FOV 35° before cropping; 460 by 460 pixels; fundus photograph cropped around the optic nerve head — 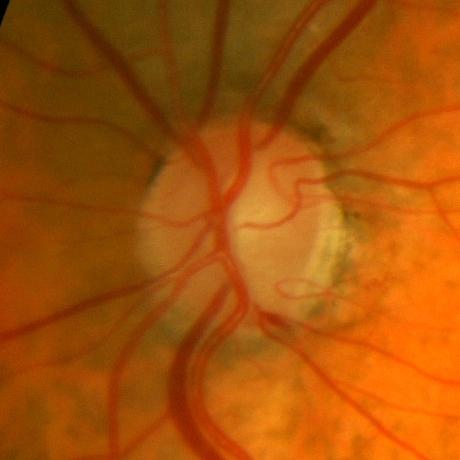
No evidence of glaucoma.